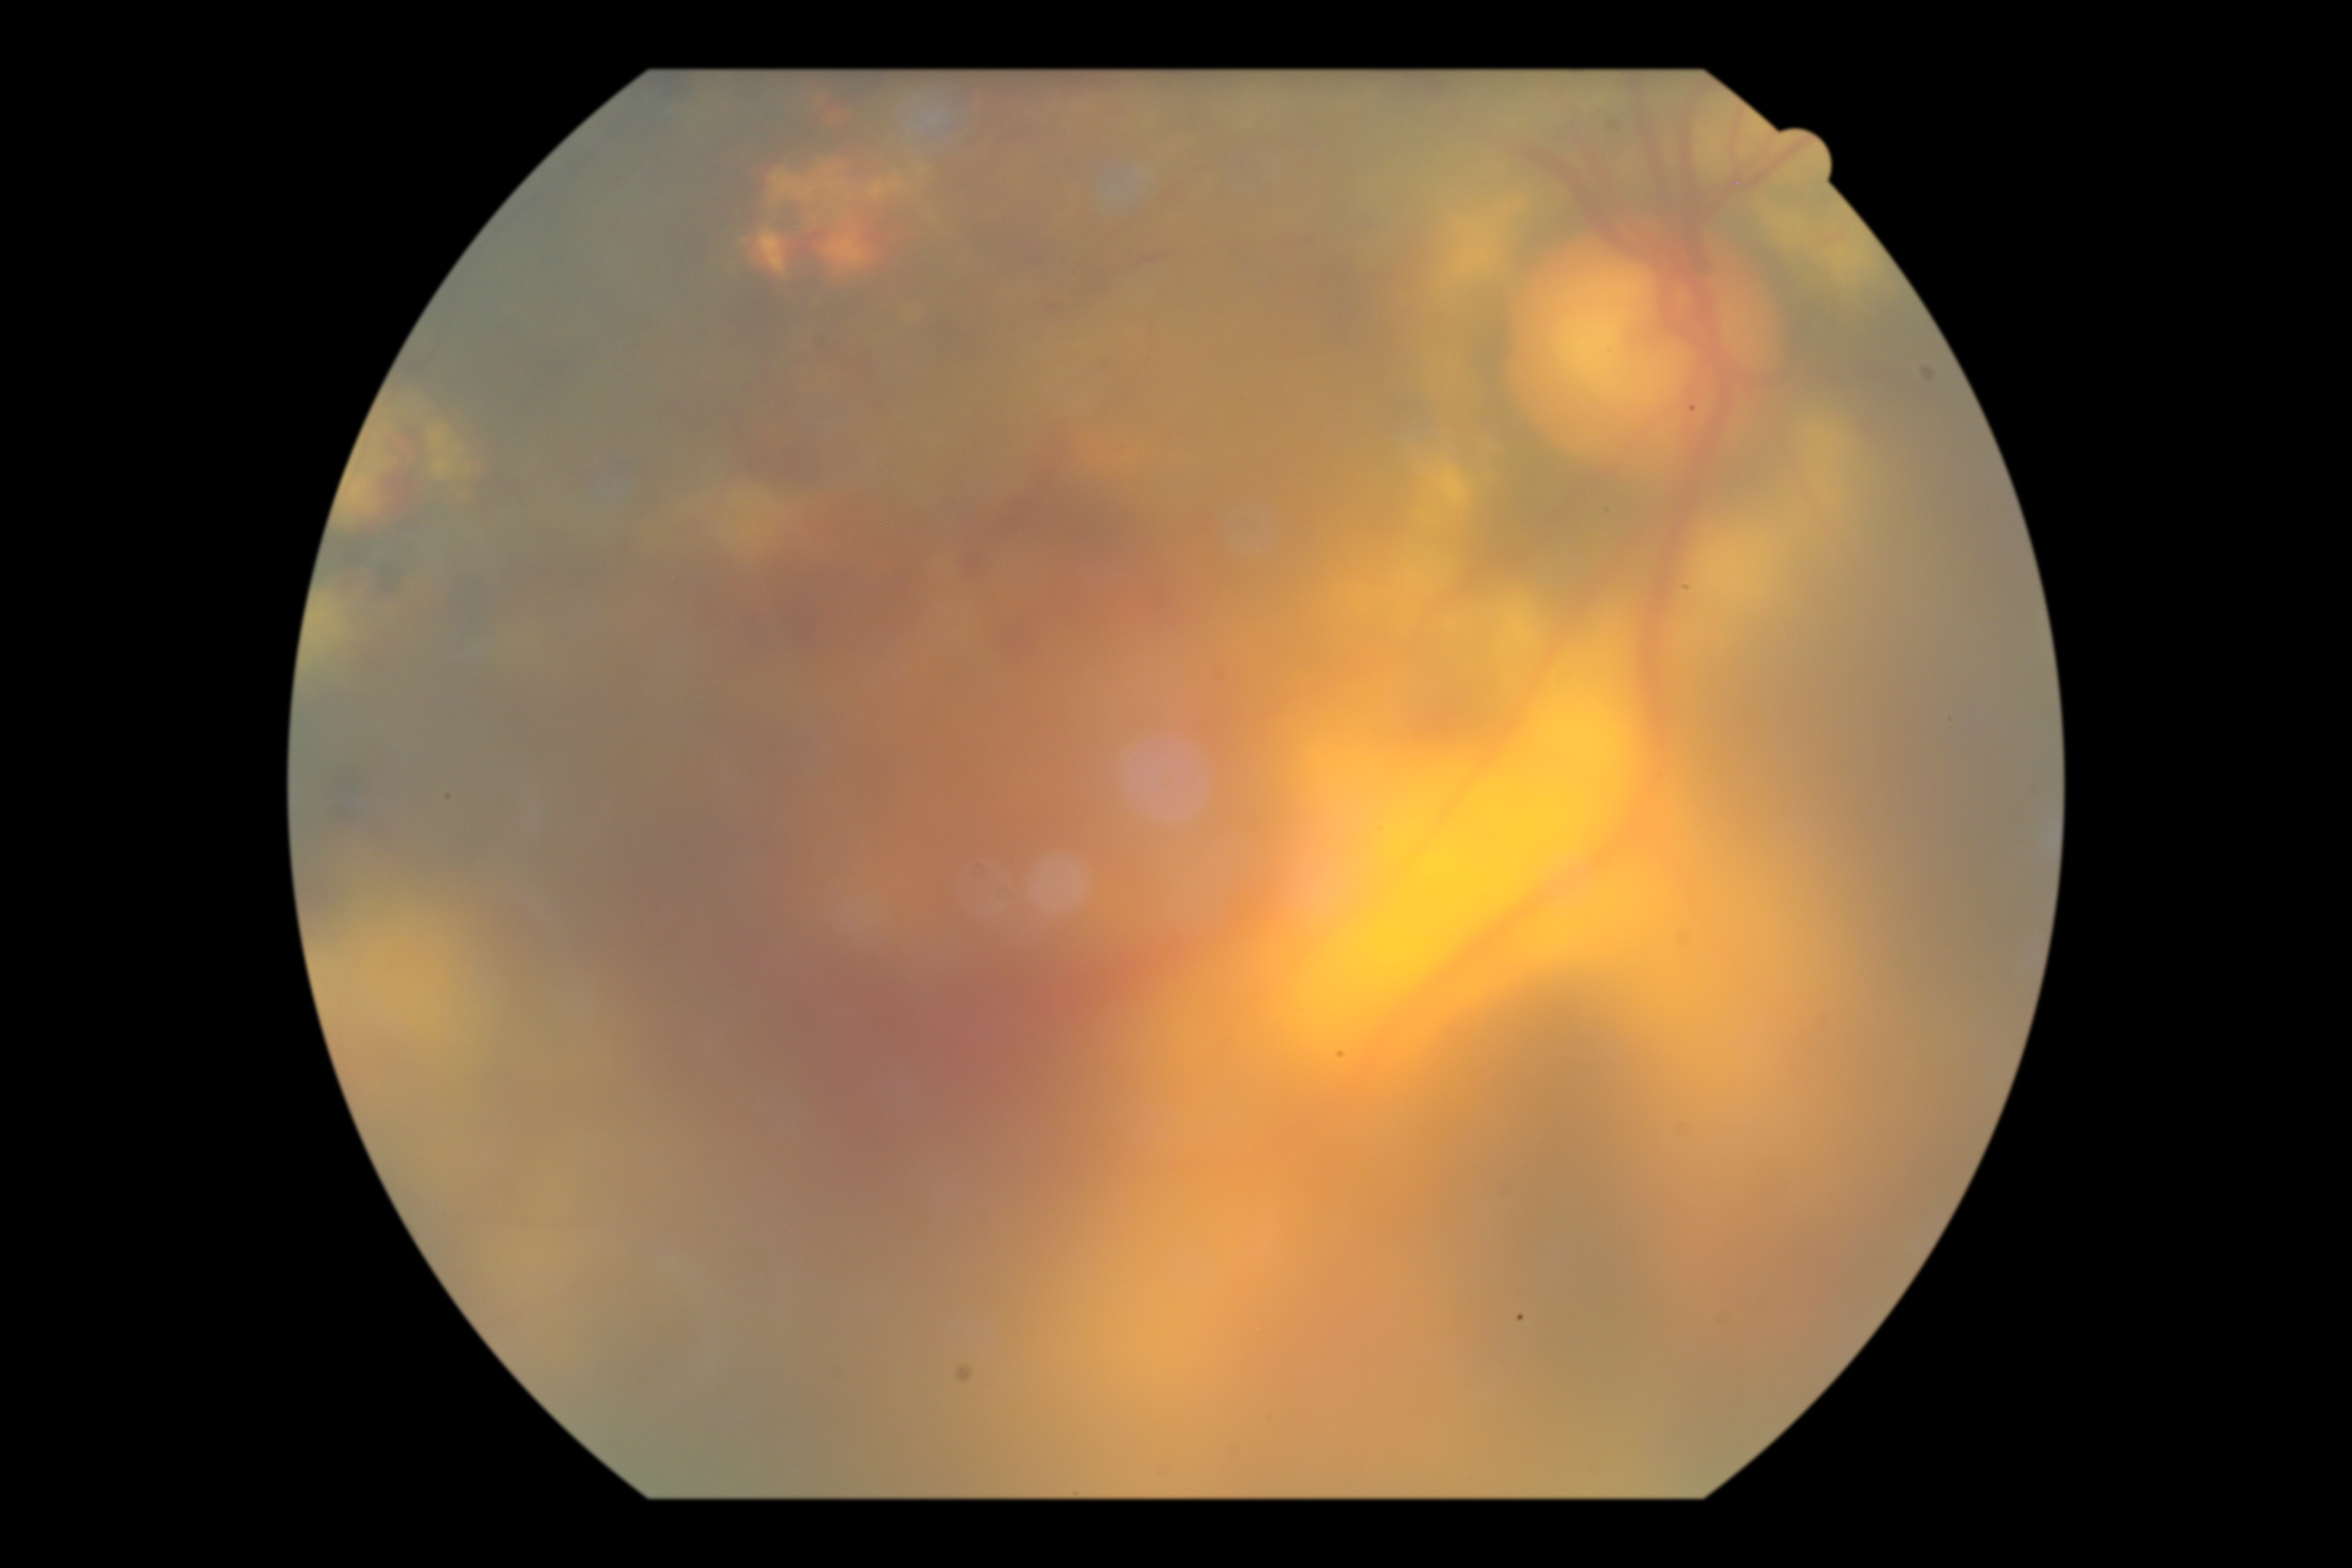

{
  "dr_category": "proliferative diabetic retinopathy",
  "dr_grade": "PDR (grade 4) — neovascularization and/or vitreous/pre-retinal hemorrhage"
}